Phoenix ICON wide-field infant fundus image; Phoenix ICON, 100° FOV — 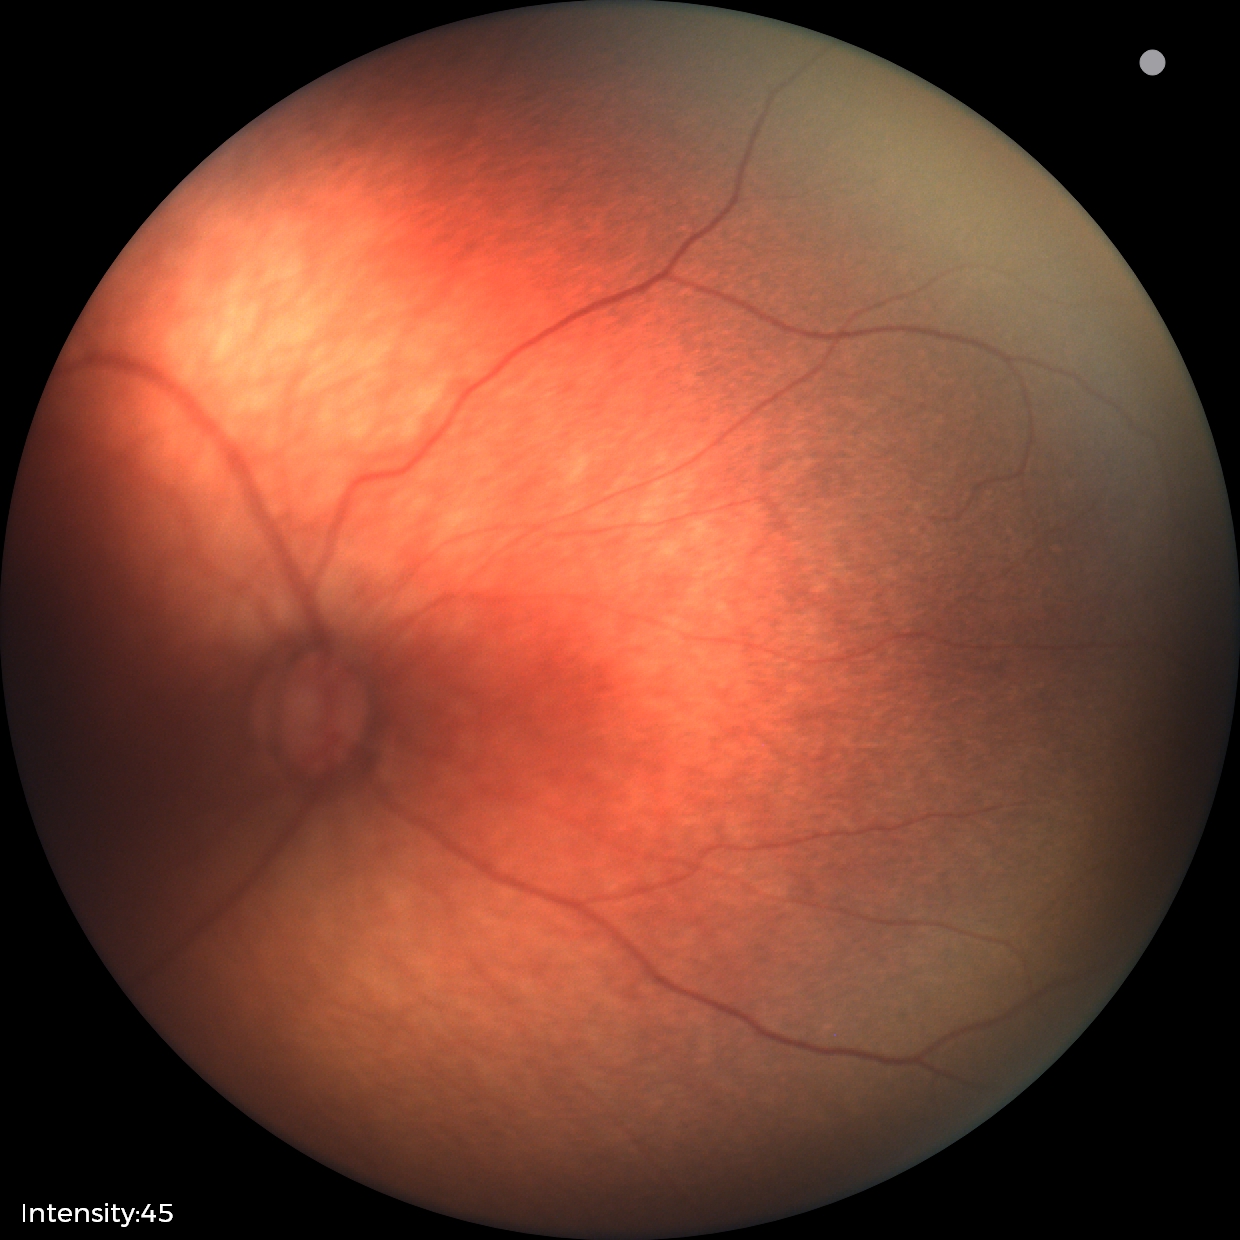
Q: What was the screening finding?
A: normal retinal appearance